2212x1659px
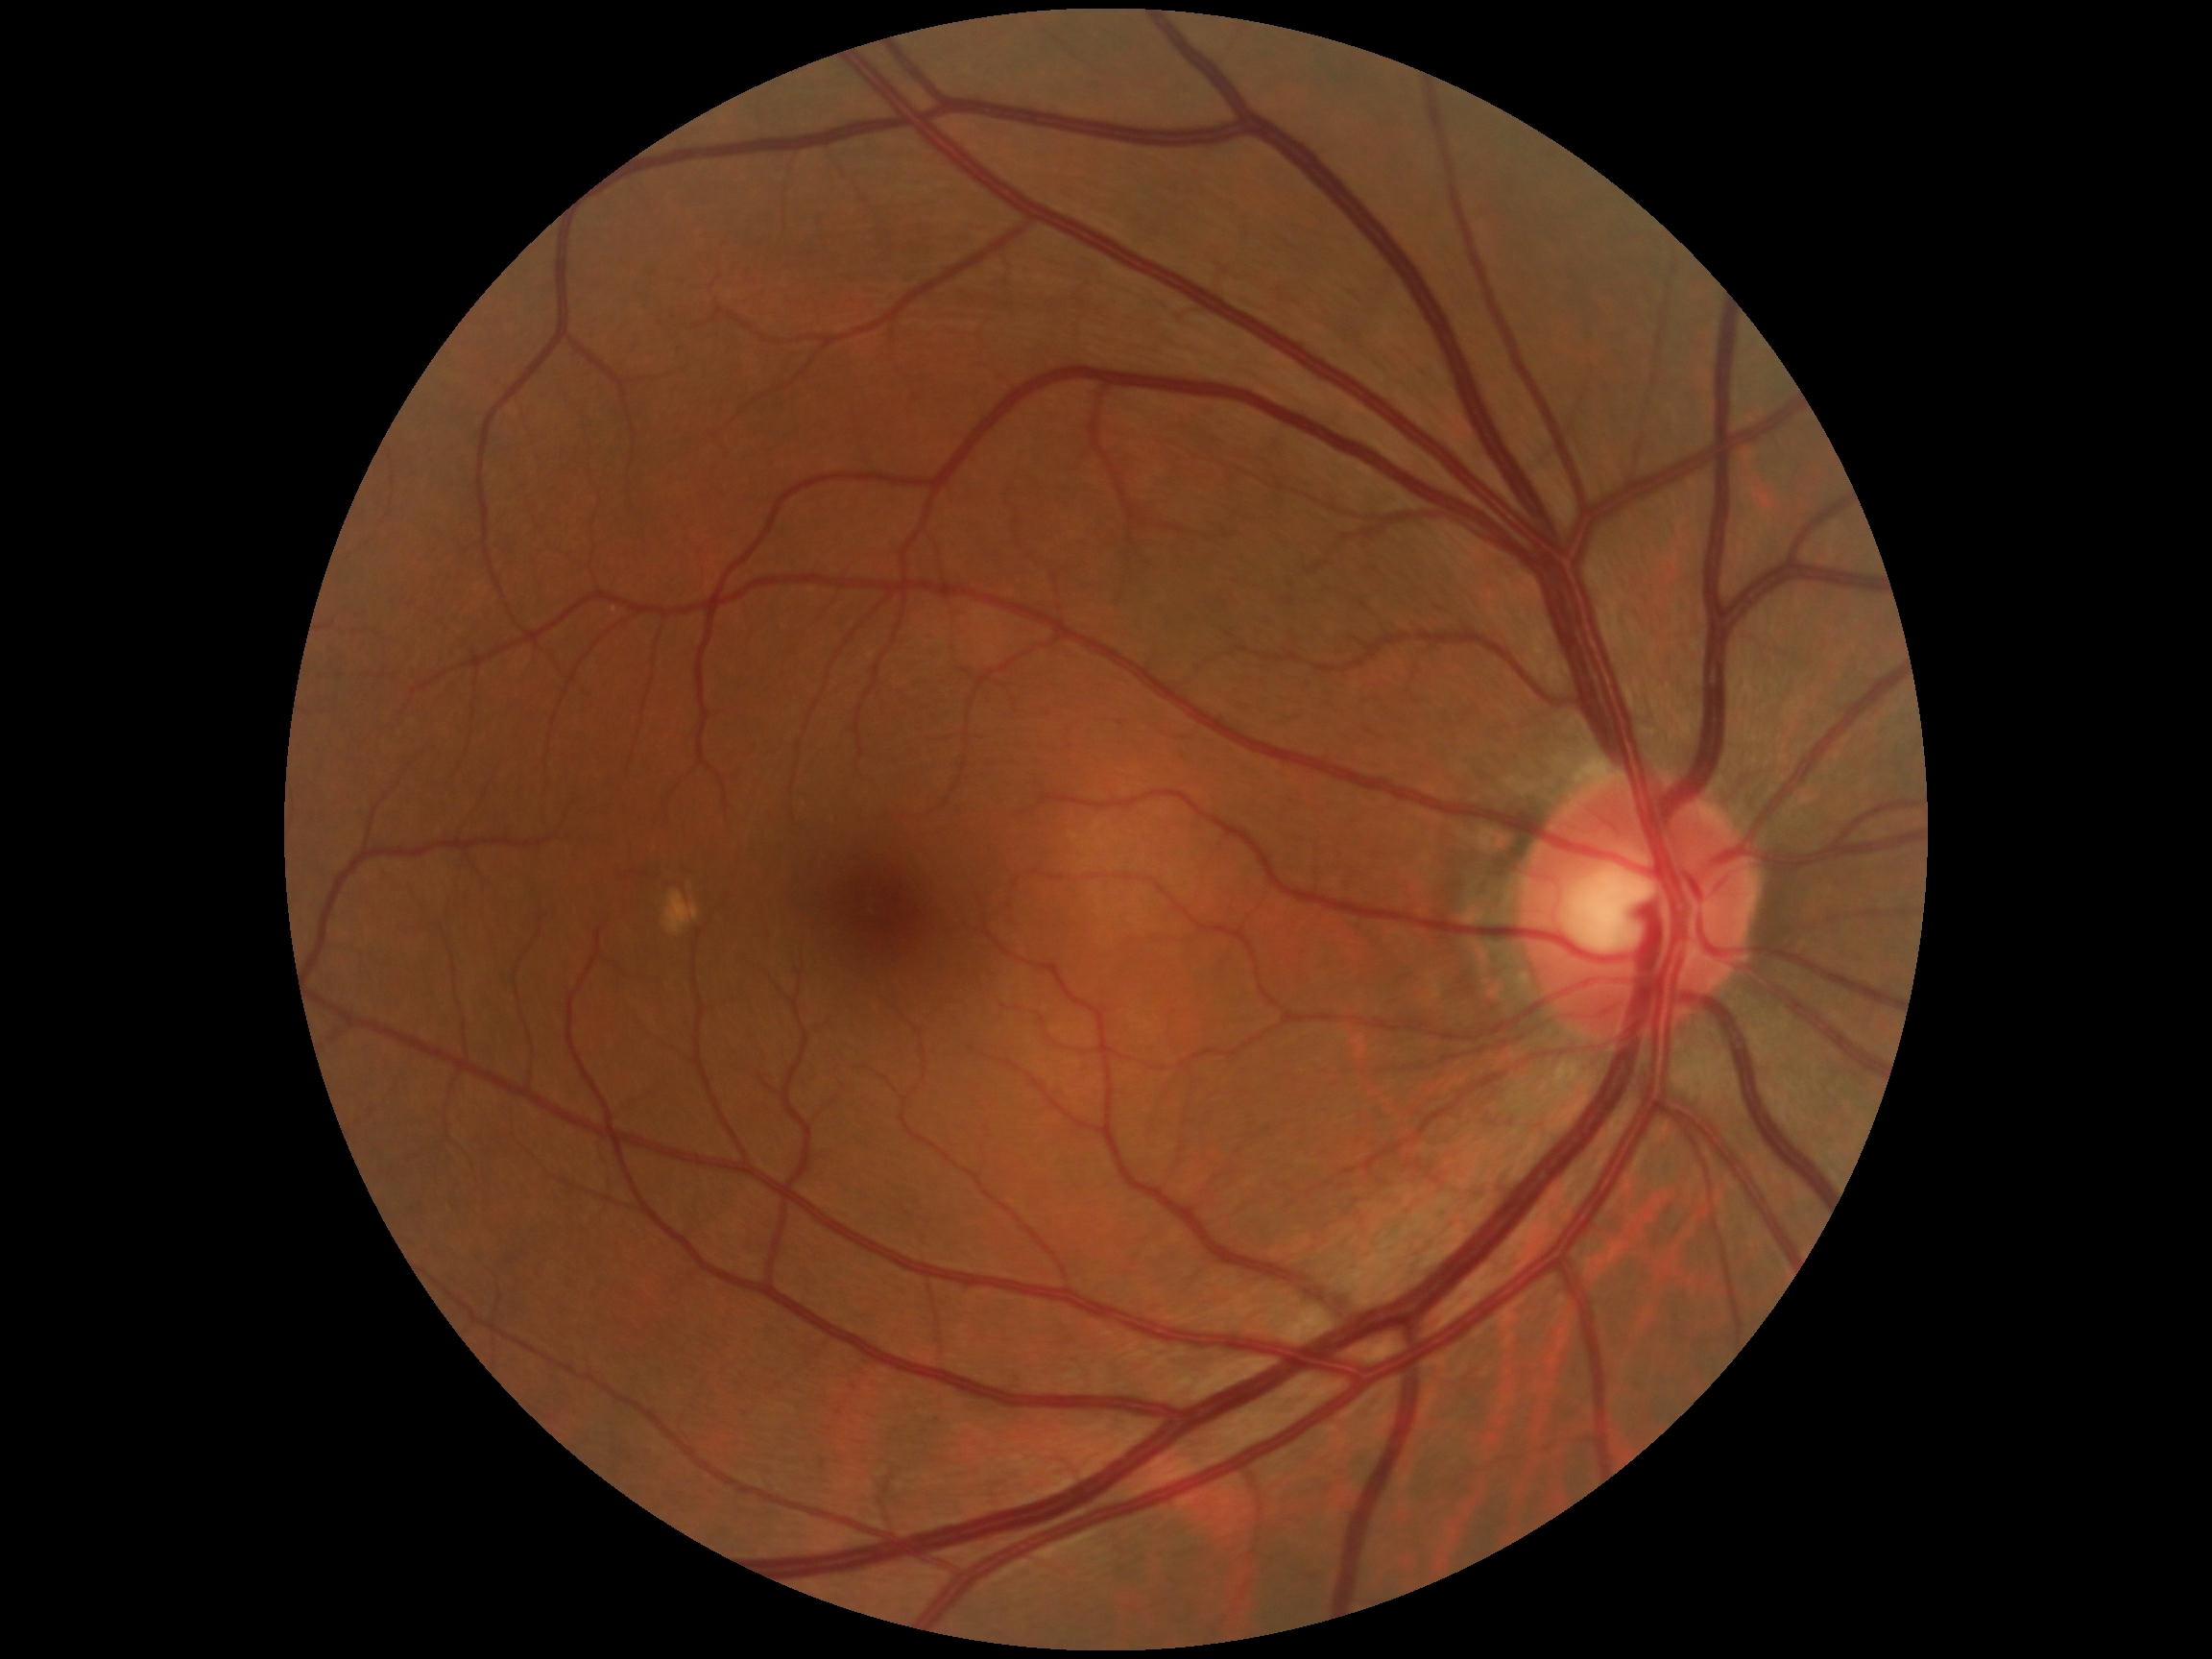

dr_impression: no DR findings
dr_grade: 0 (no apparent retinopathy) — no visible signs of diabetic retinopathy